2346x1568: 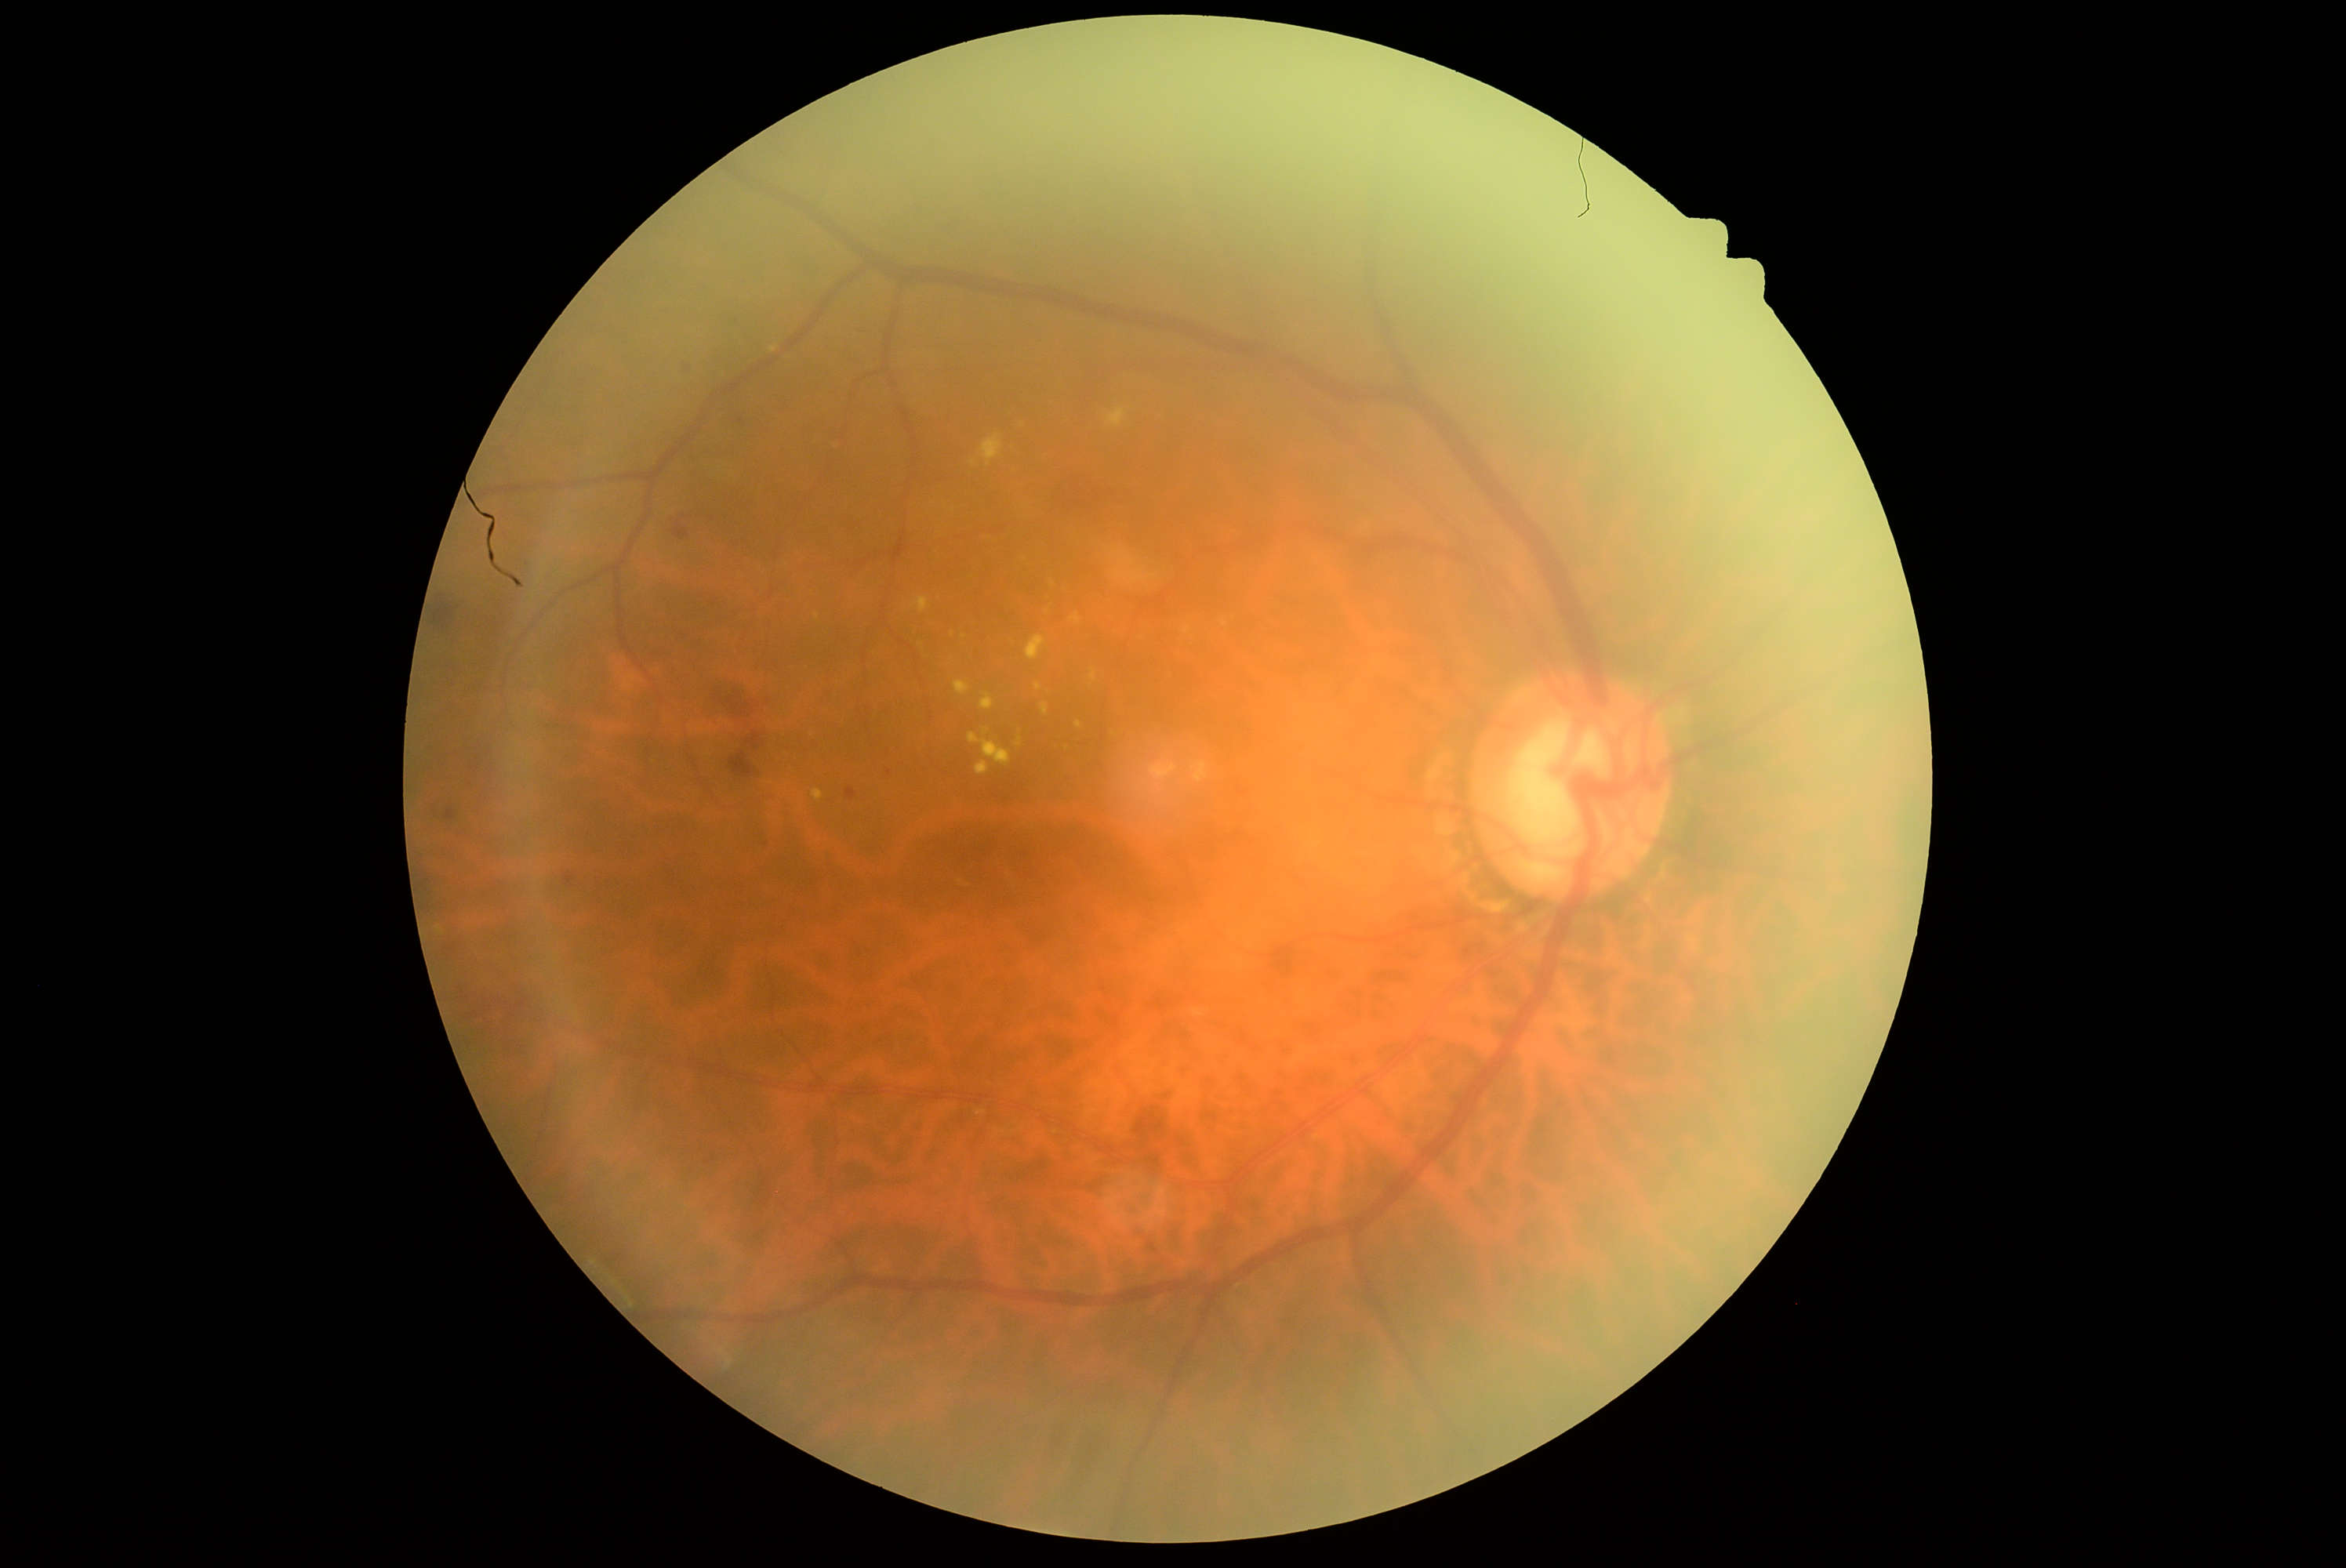
{"dr_grade": "2/4"}